Graded on the modified Davis scale · NIDEK AFC-230.
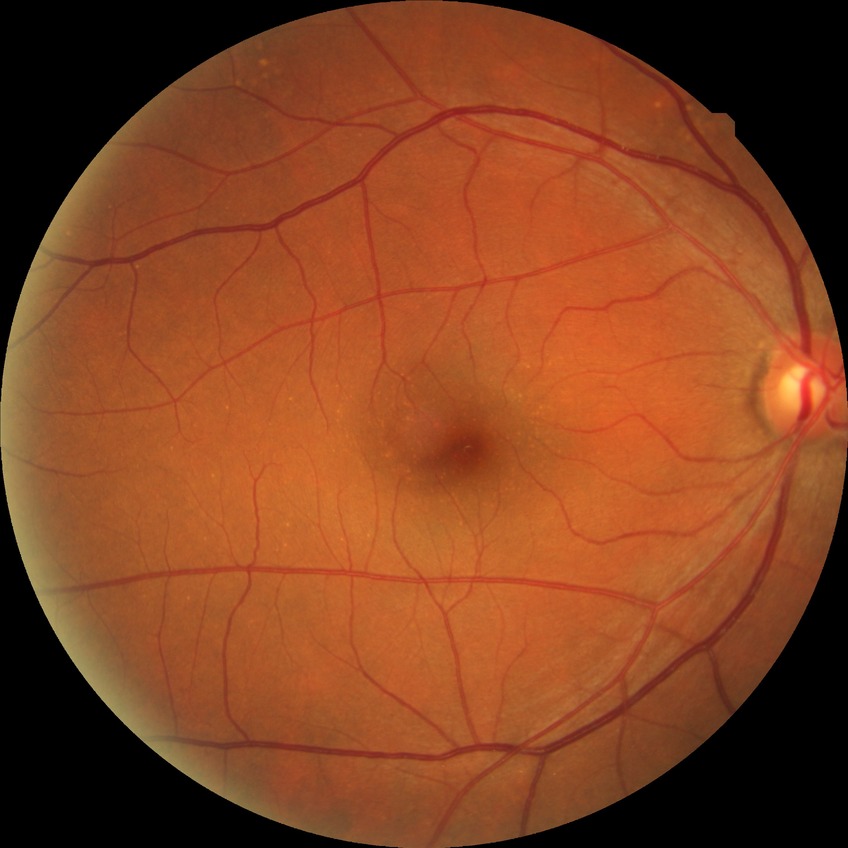

davis_grade: NDR